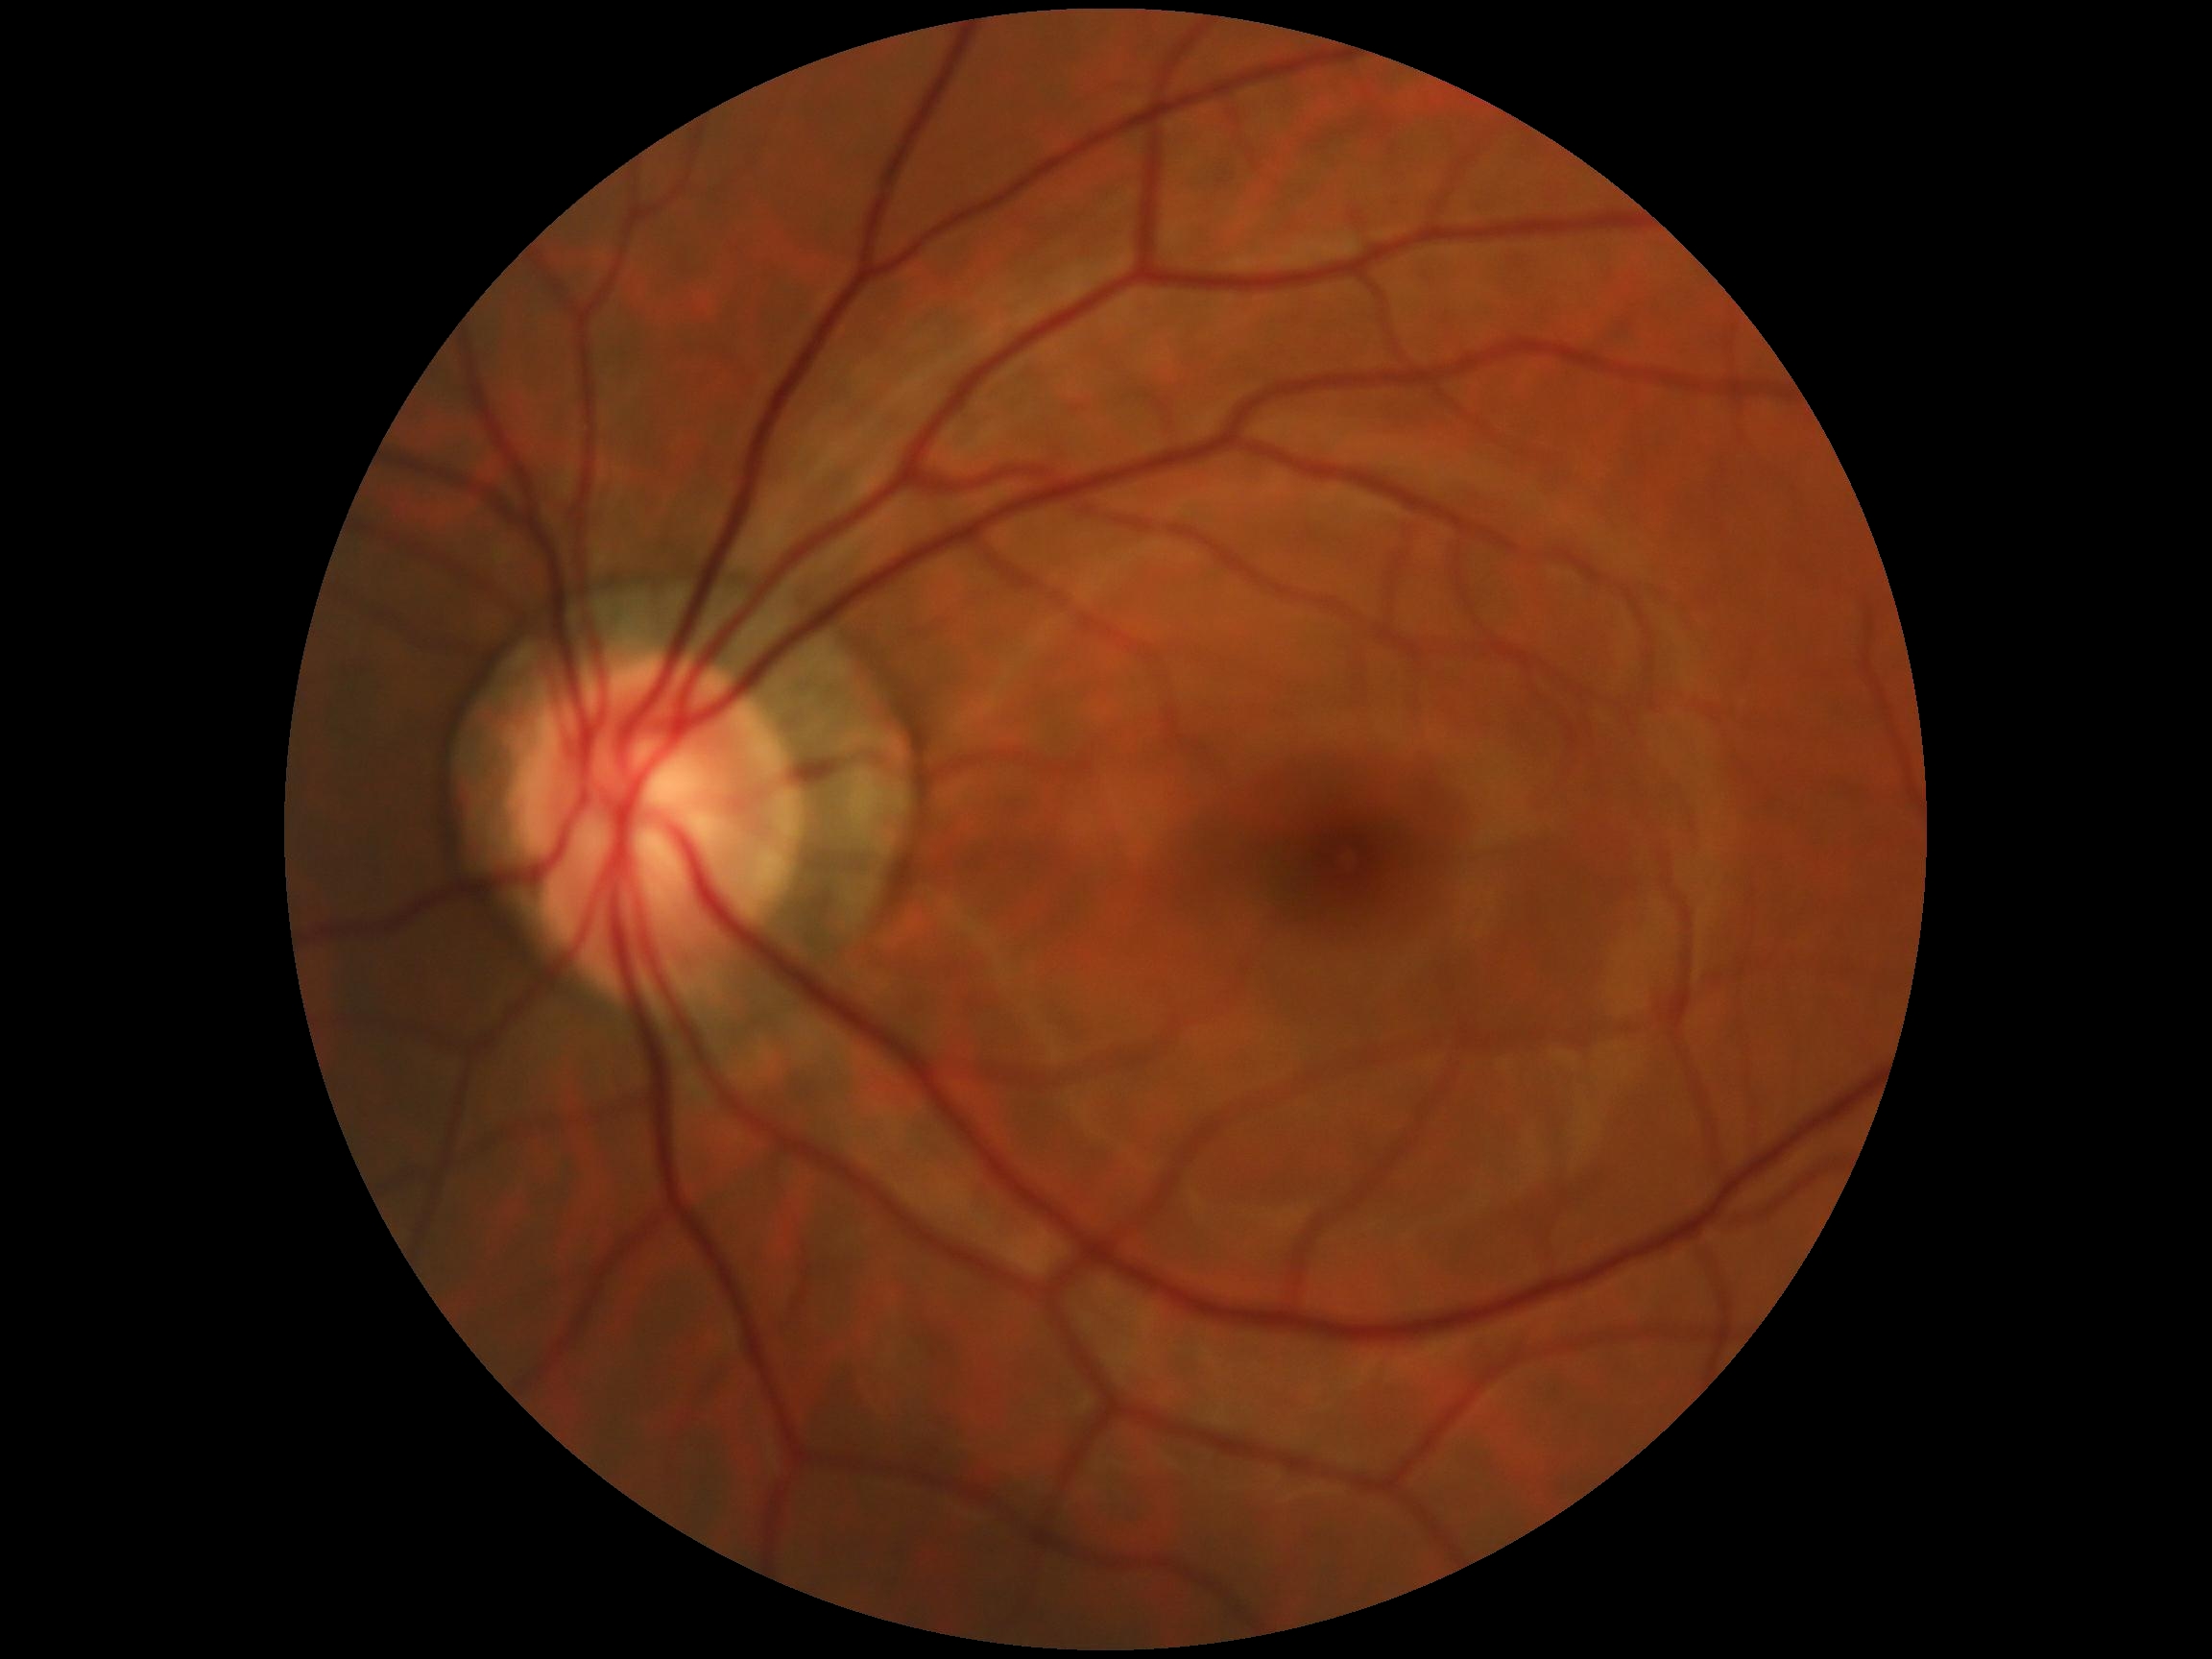
No apparent diabetic retinopathy. Diabetic retinopathy grade is 0/4.